45° field of view
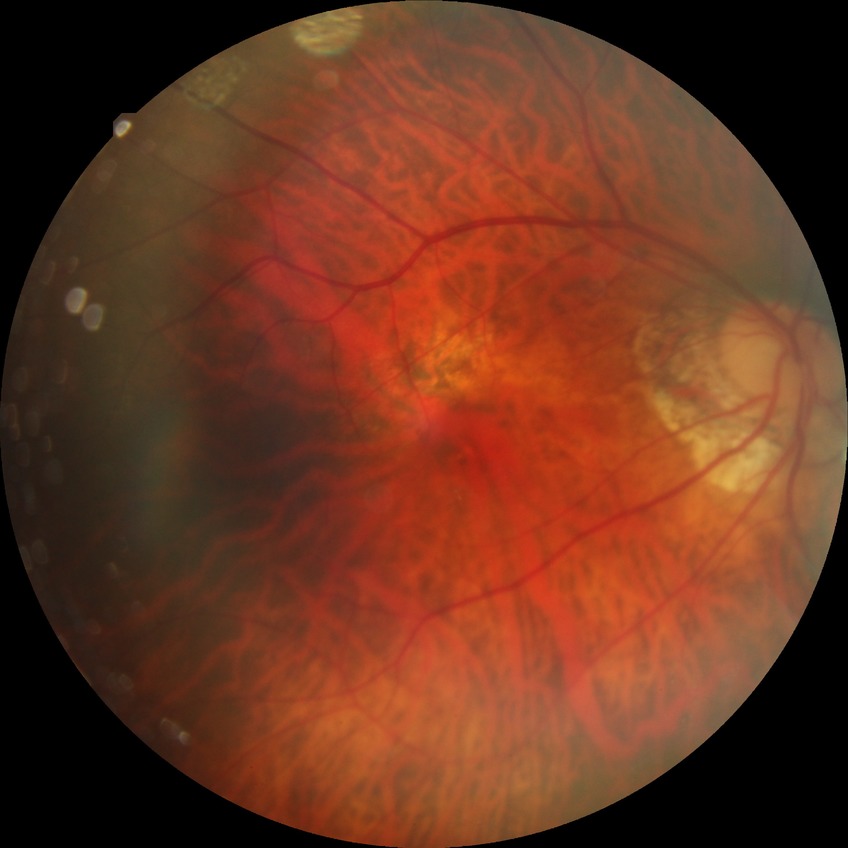
{
  "davis_grade": "NDR (no diabetic retinopathy)"
}